Ultra-widefield fundus mosaic; 200° FOV; 1924 x 1556 pixels — 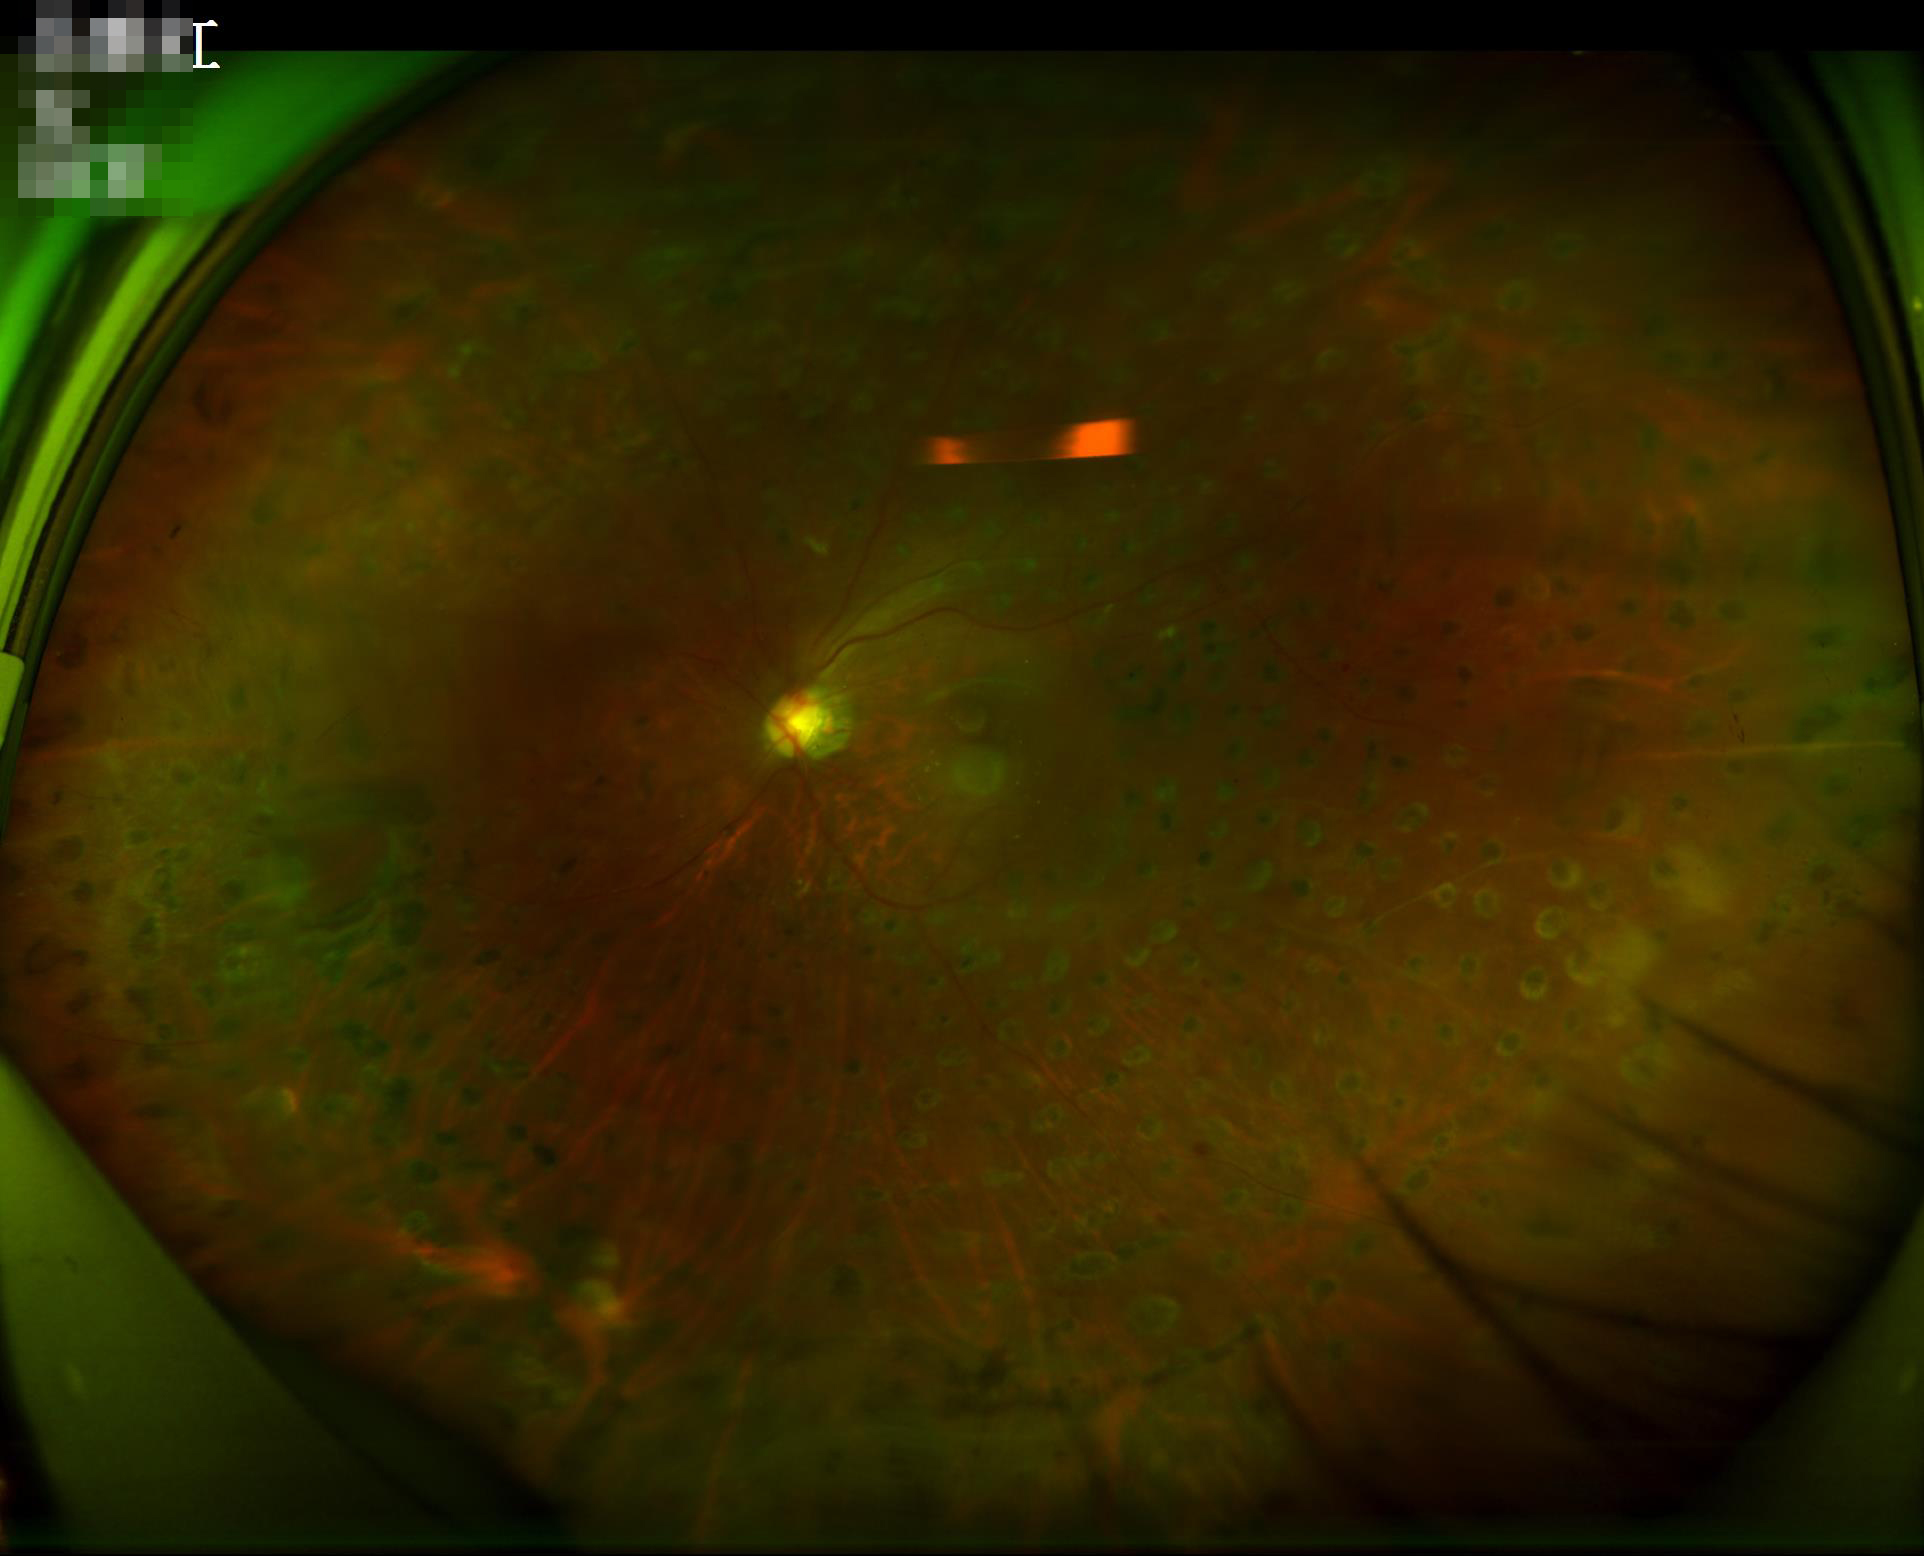 Poor dynamic range.
Overall image quality is good.
No noticeable blur.
Illumination and color balance are good.